Clarity RetCam 3, 130° FOV; wide-field fundus photograph of an infant.
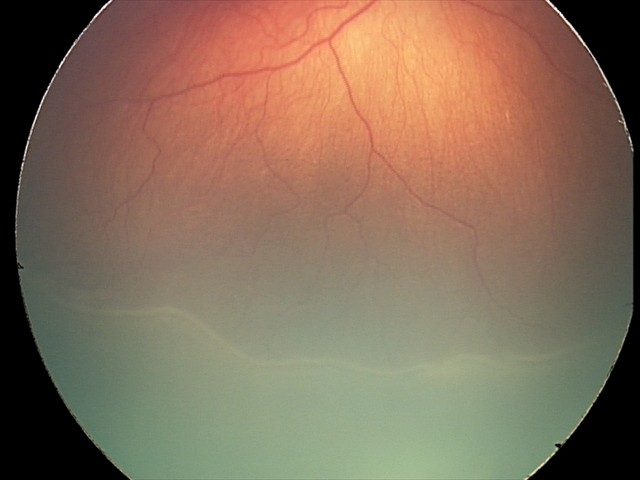 Plus disease: absent — posterior pole vessels without abnormal dilation or tortuosity, ROP grade: stage 2.